RetCam wide-field infant fundus image:
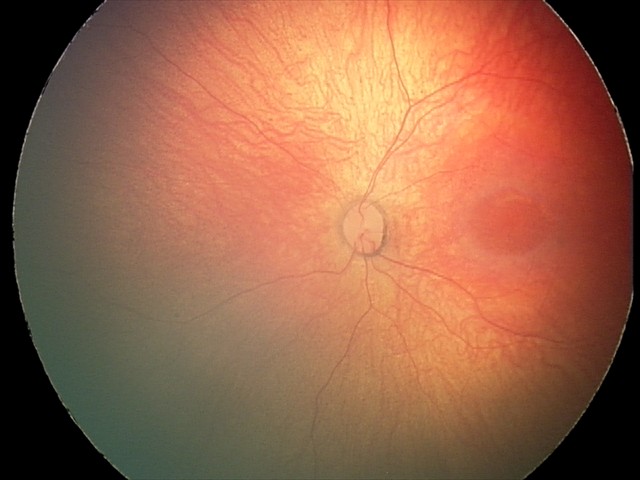

Impression: physiological retinal finding.